Camera: NIDEK AFC-230 — 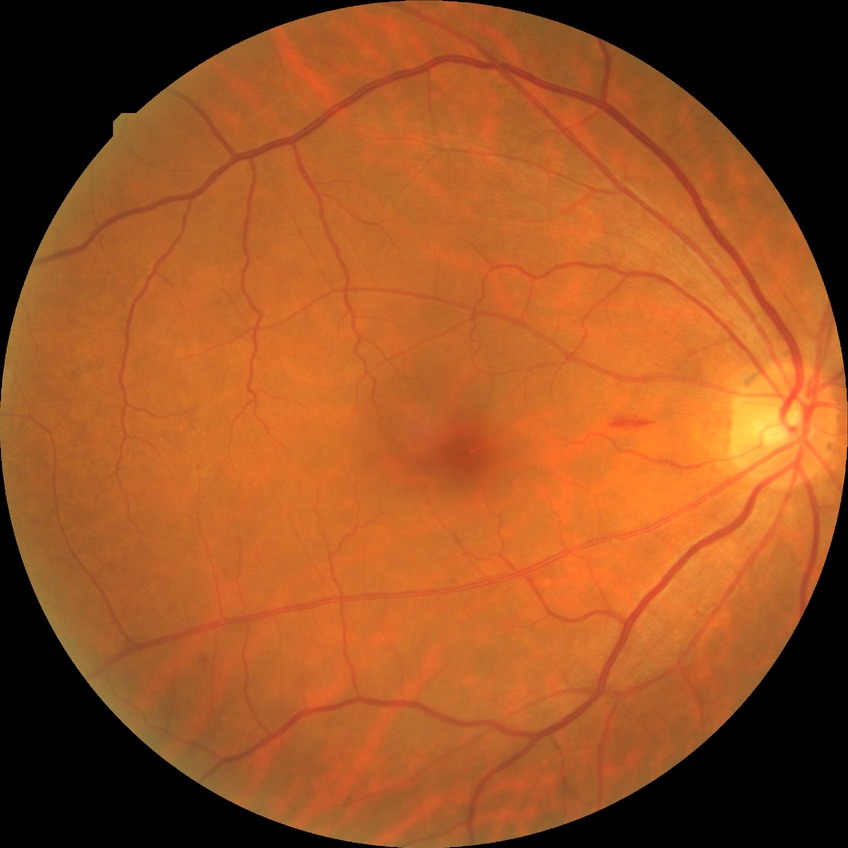

modified Davis grade = SDR.